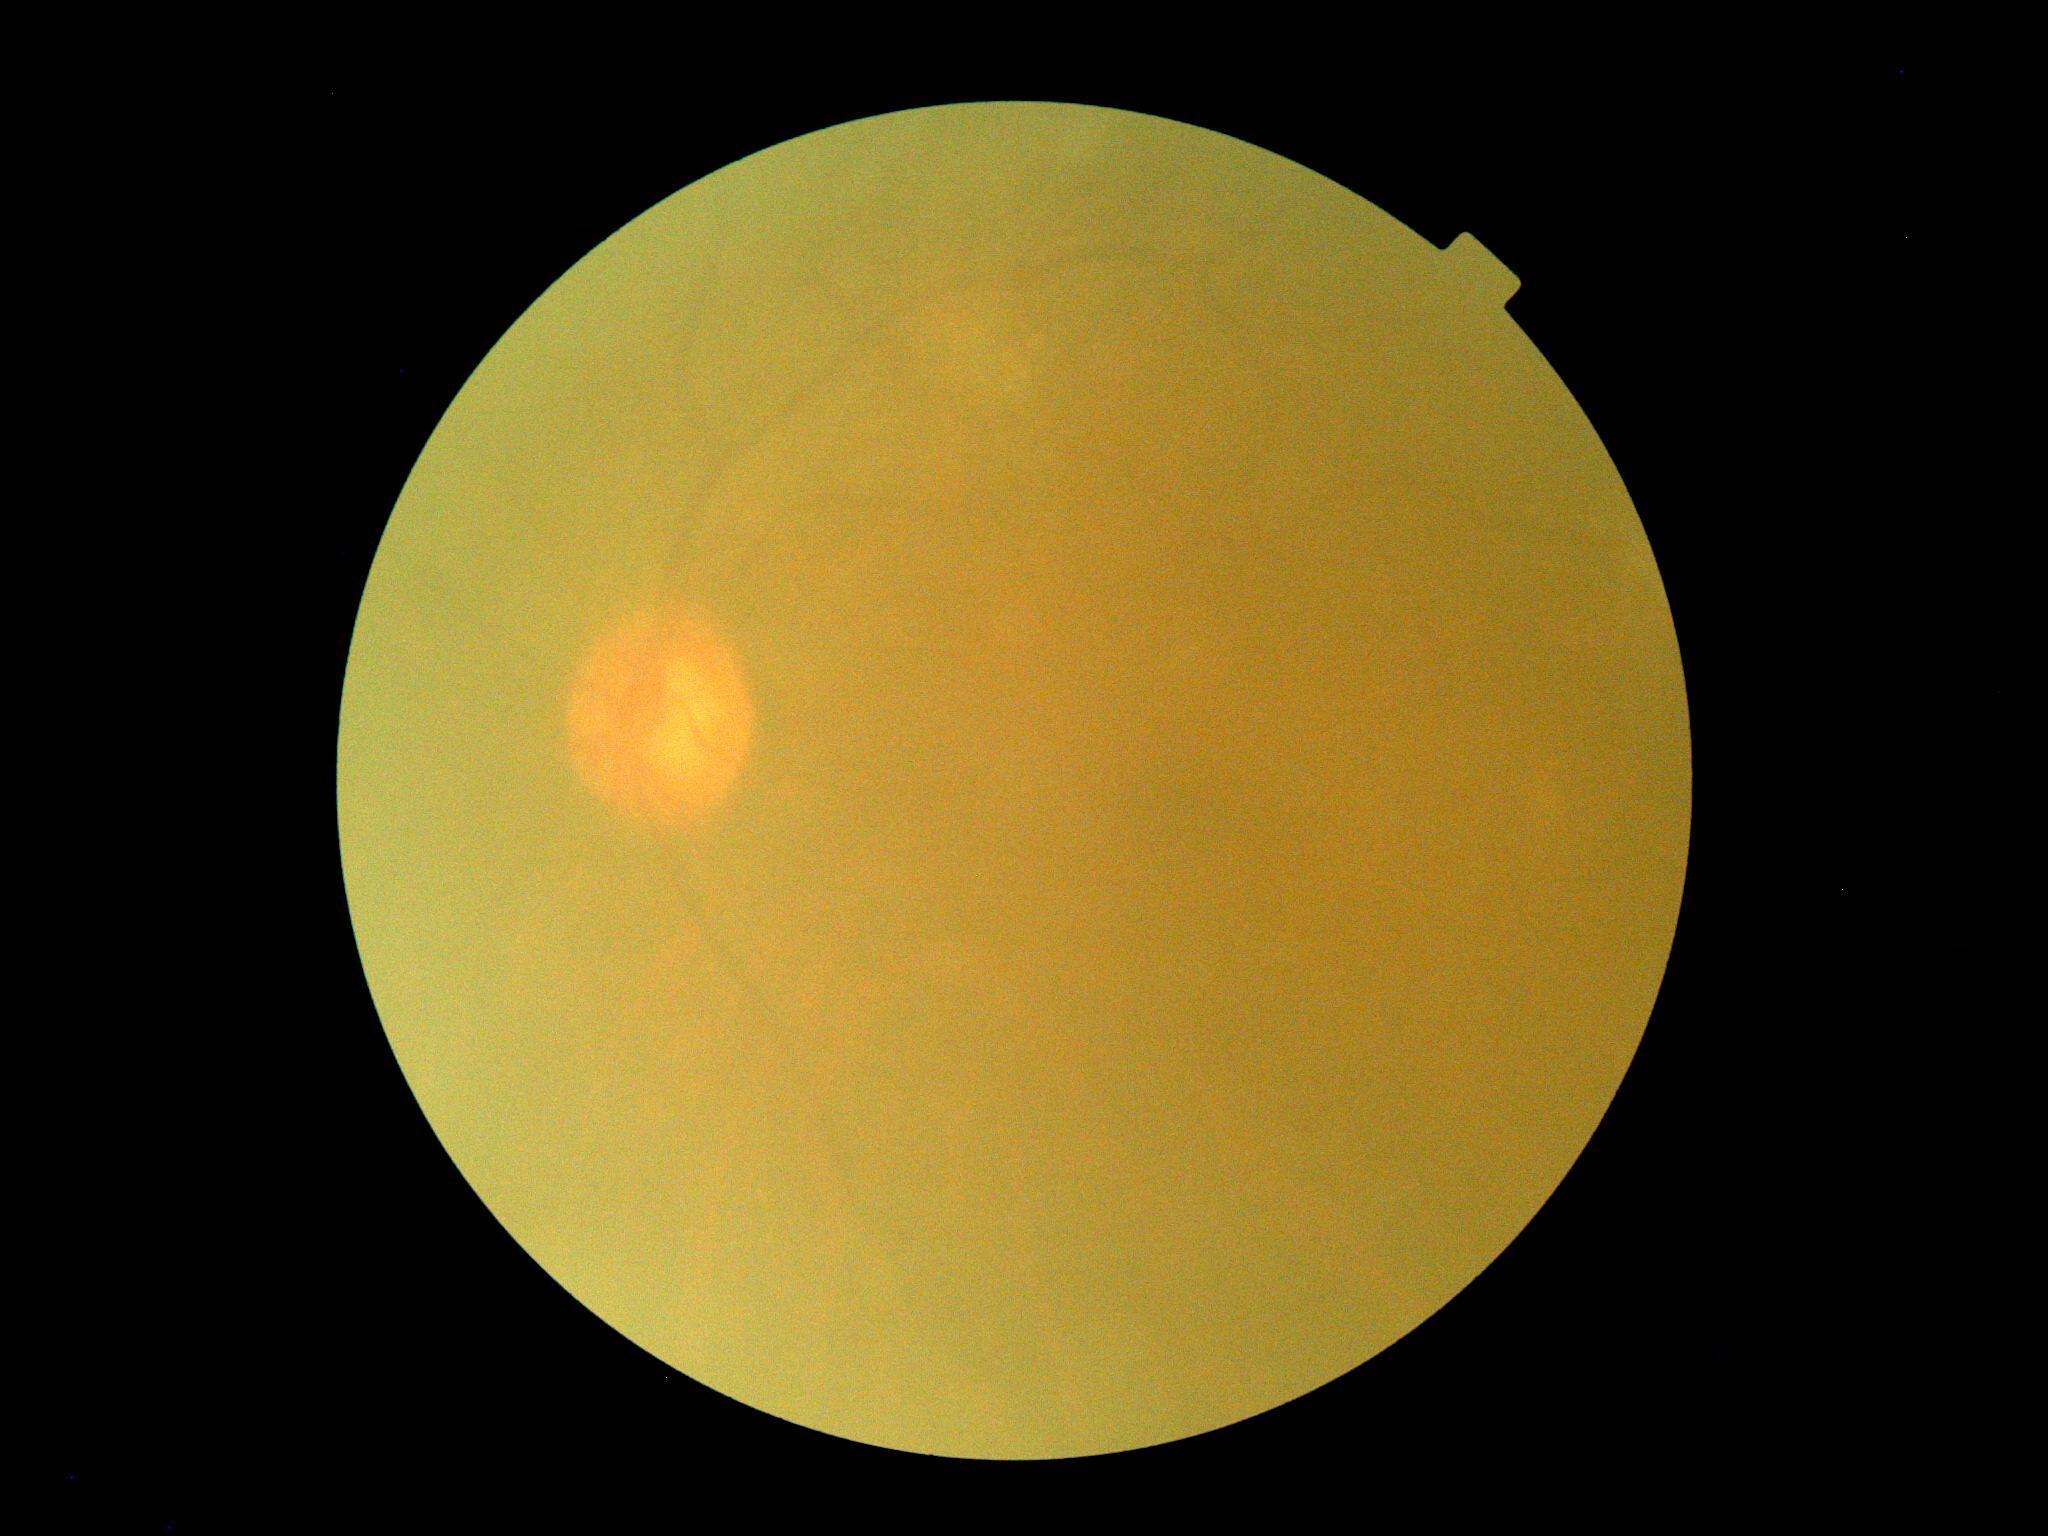 DR grade is ungradable. Ungradable image — DR severity cannot be determined.